45-degree field of view — 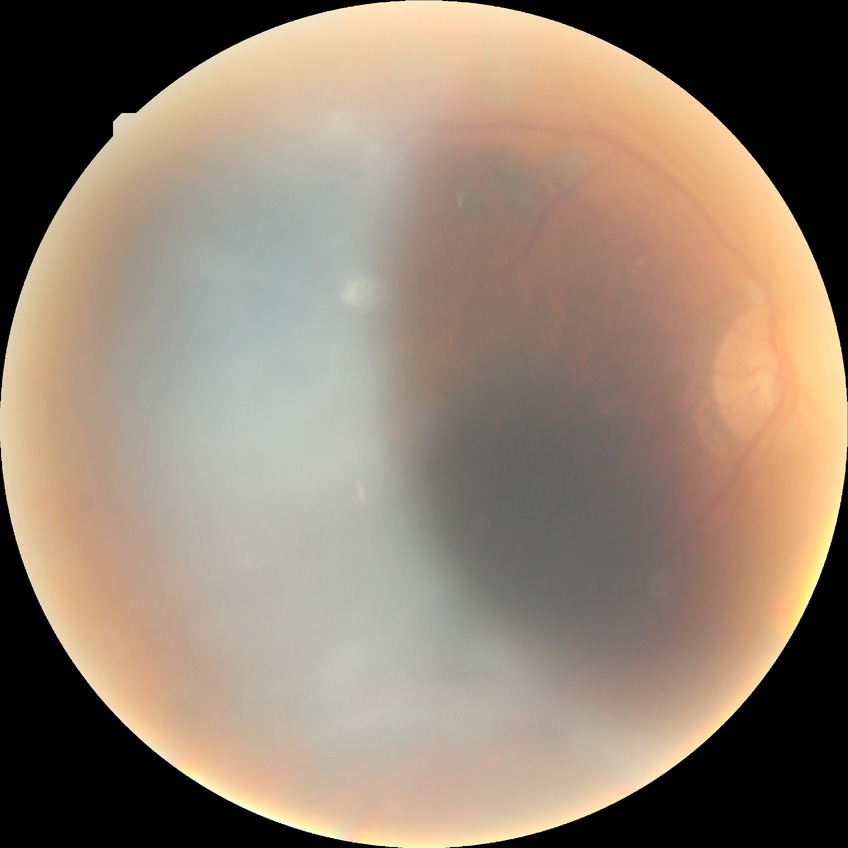
diabetic retinopathy (DR): PDR (proliferative diabetic retinopathy).